Acquired with a NIDEK AFC-230
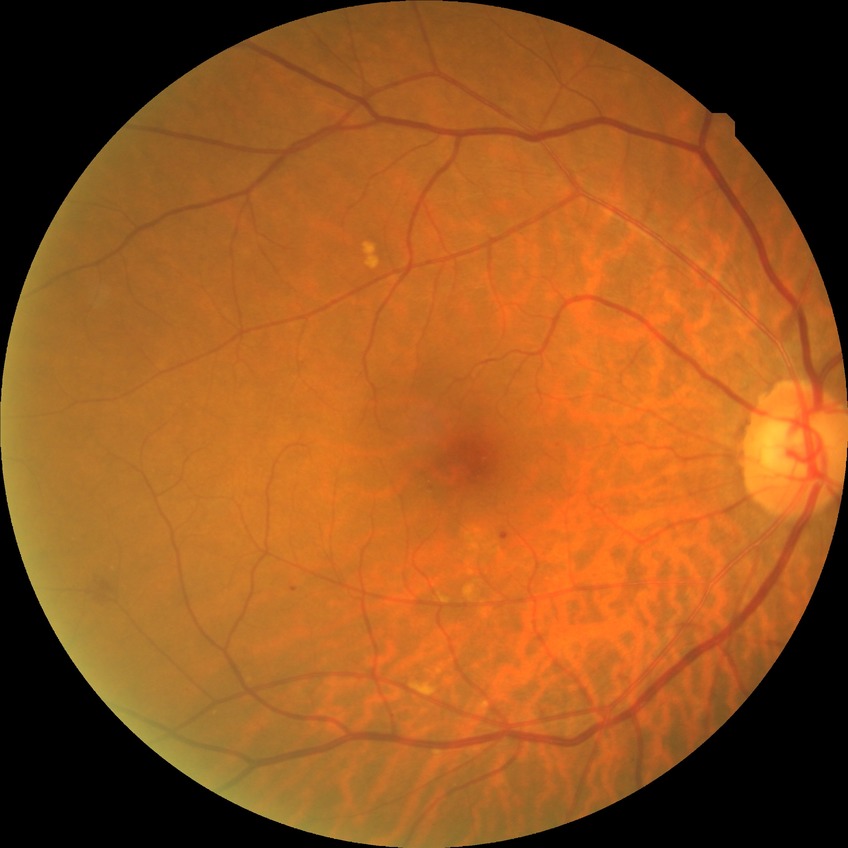

Assessment:
- diabetic retinopathy (DR): no diabetic retinopathy (NDR)